45° field of view.
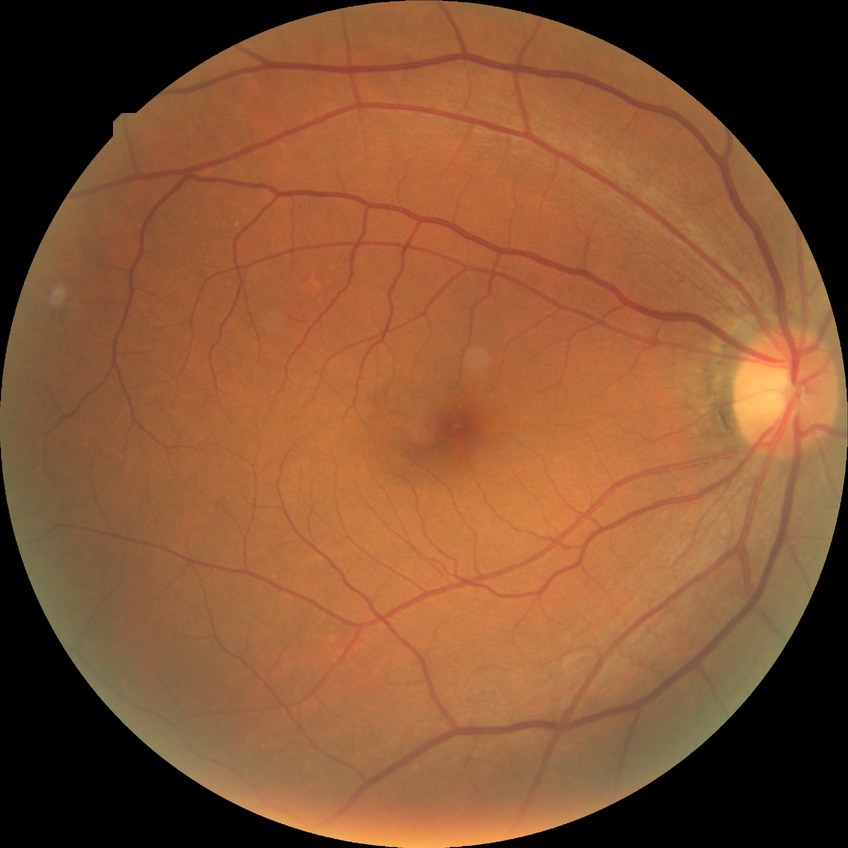 Diabetic retinopathy severity: no diabetic retinopathy.